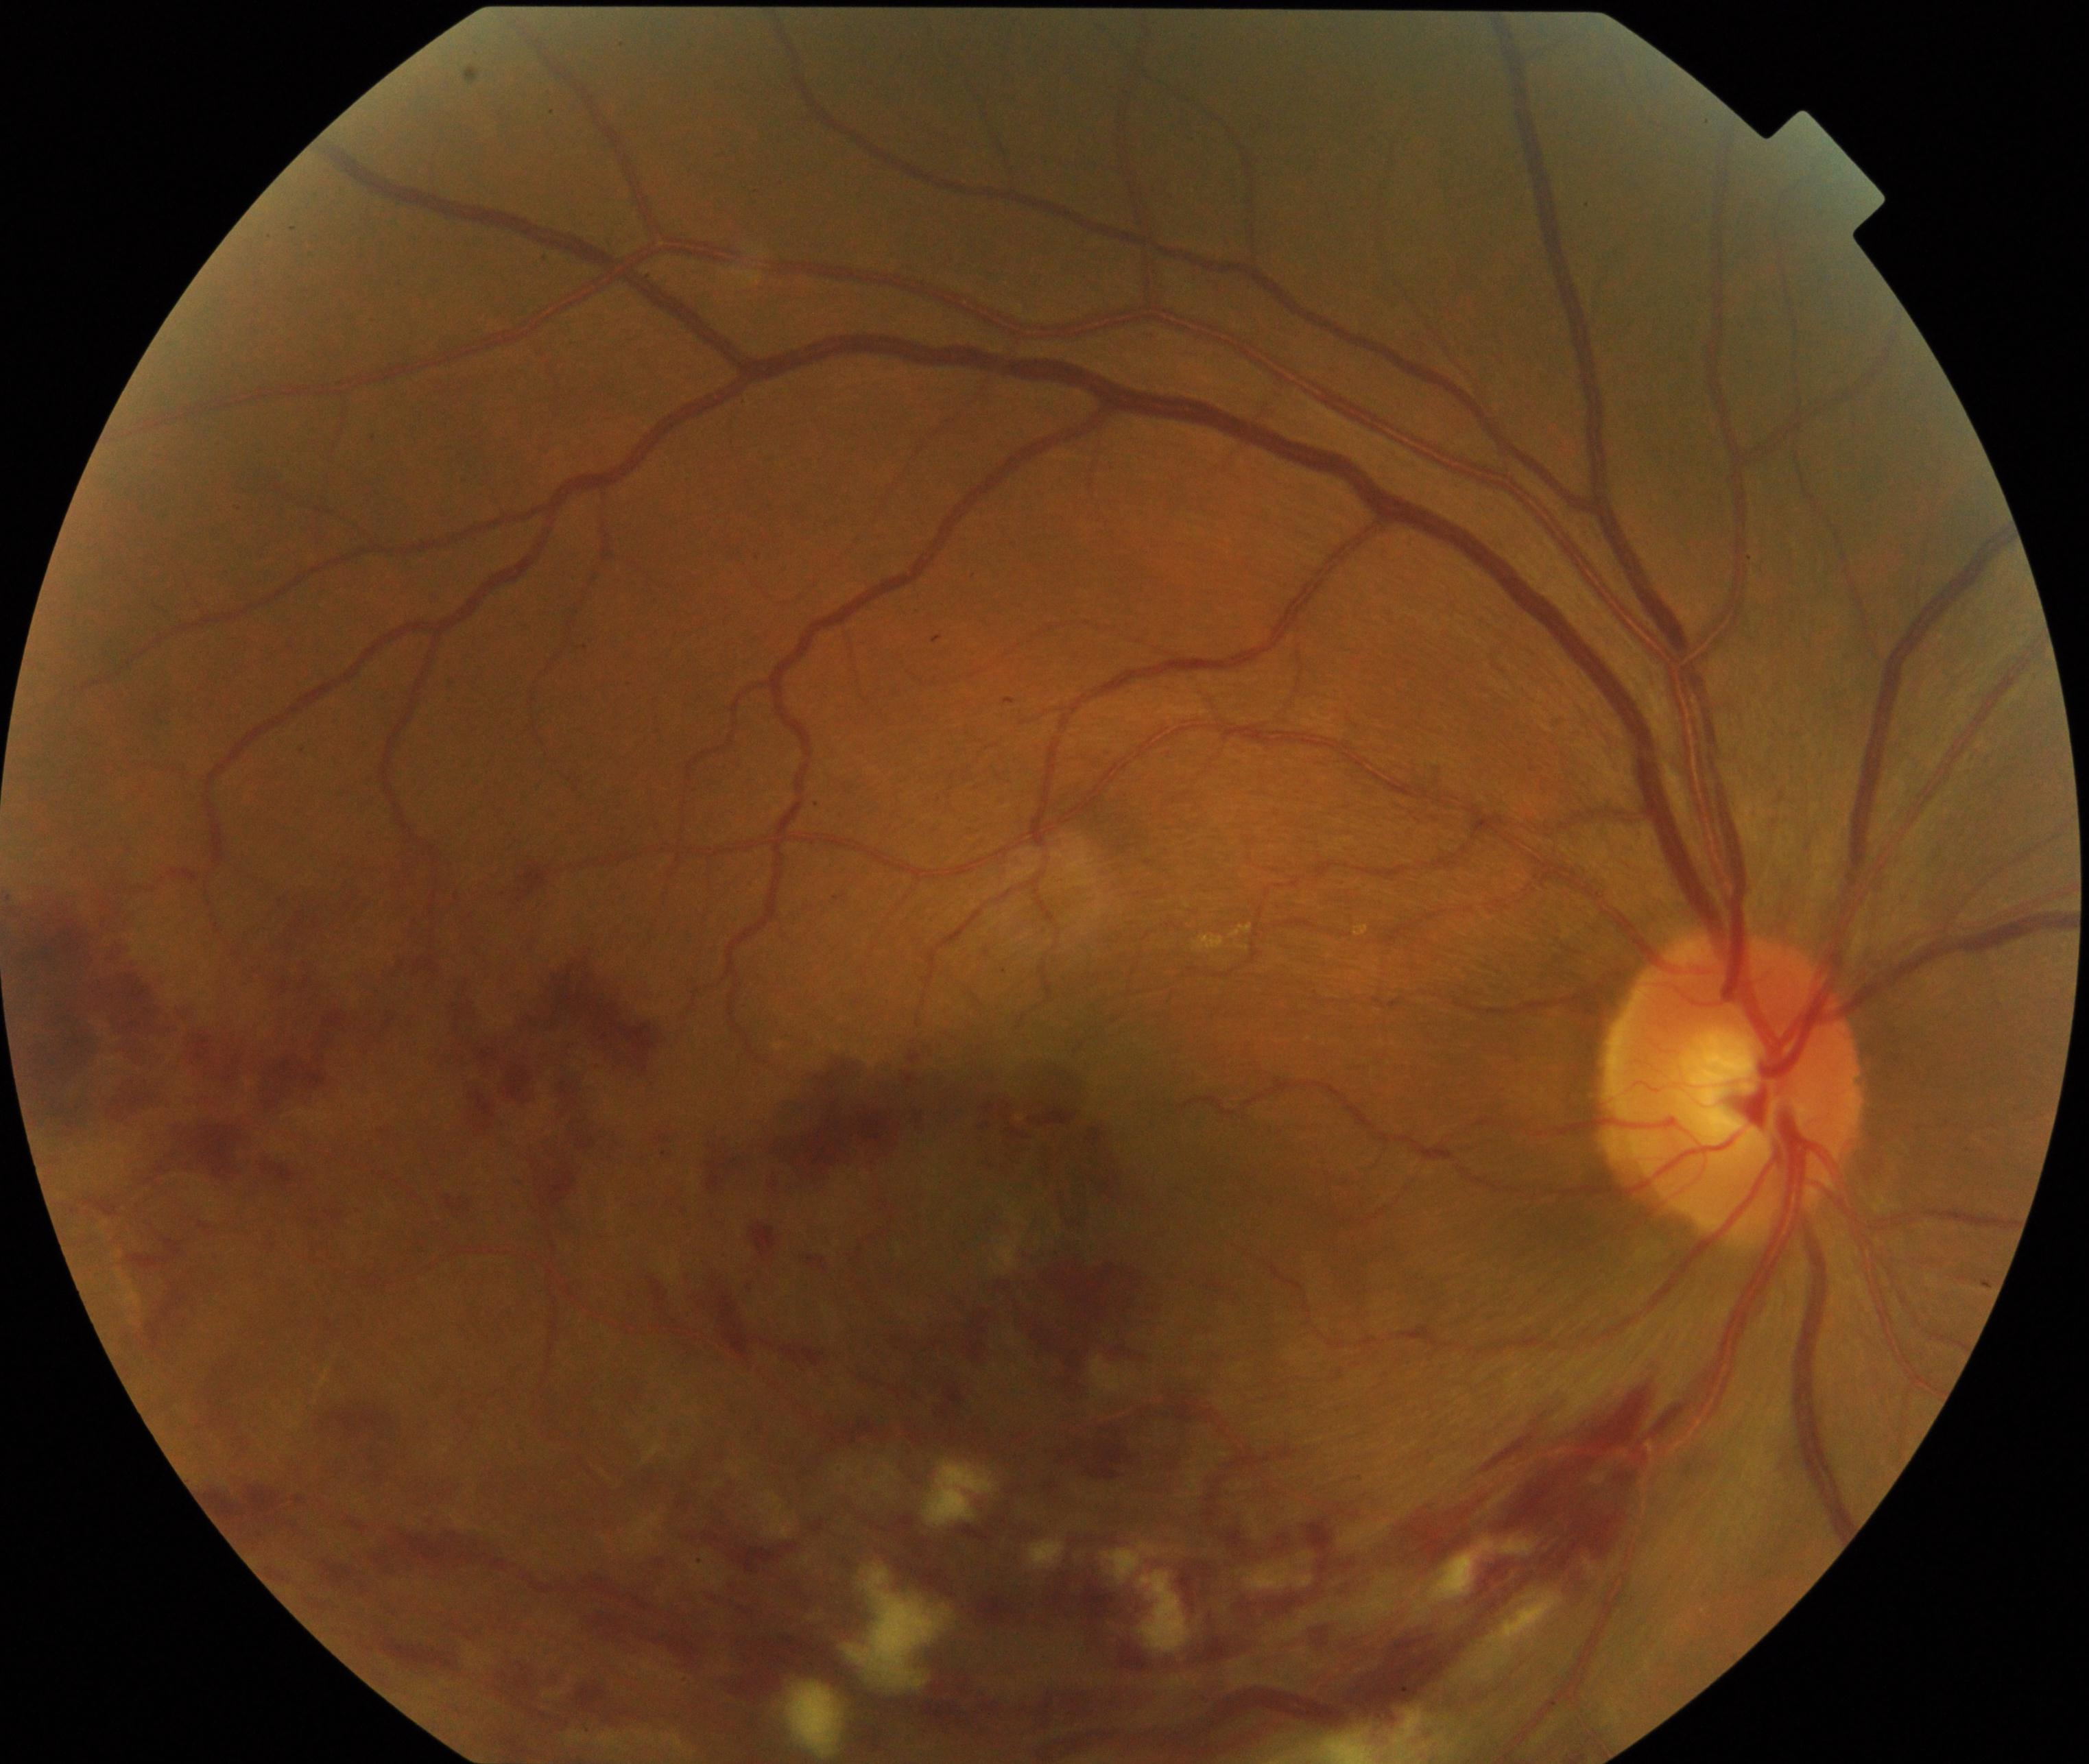

Findings: branch retinal vein occlusion.